Color fundus photograph; camera: Topcon TRC-NW8
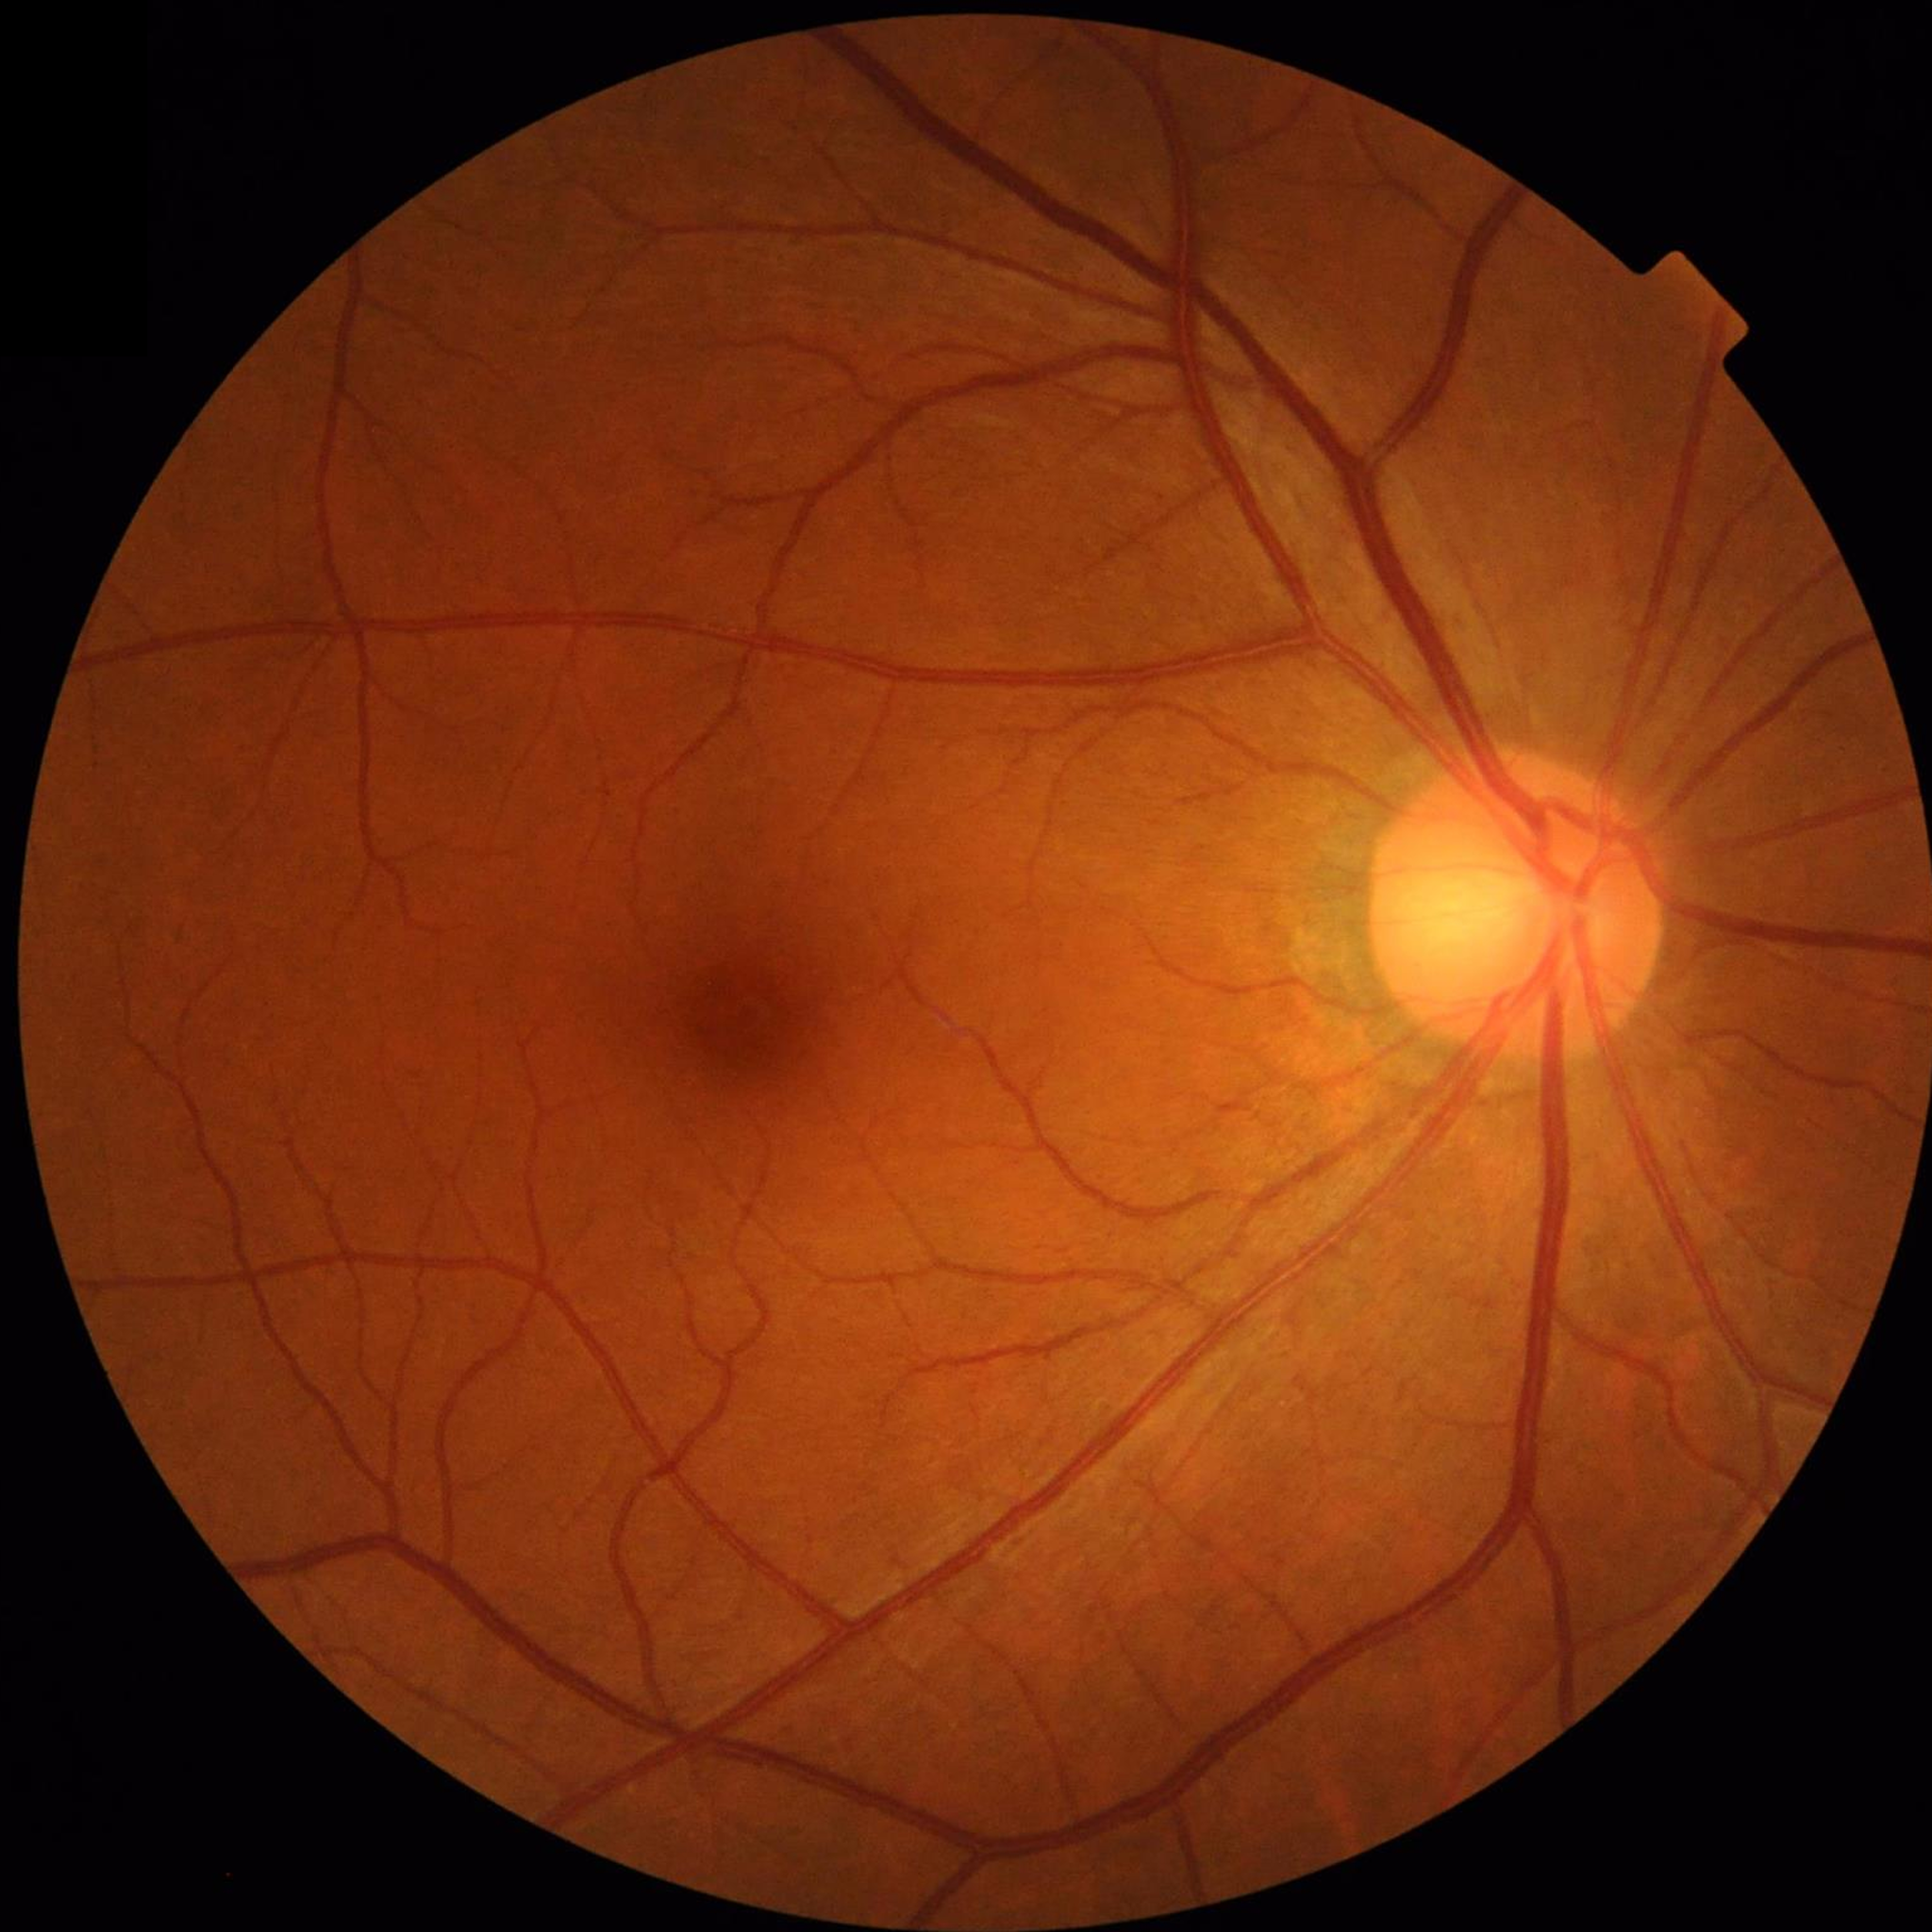 Clinical diagnosis = no AMD, DR, or glaucoma | Quality assessment = no blur, contrast adequate, illumination and color satisfactory.